1240 by 1240 pixels; Phoenix ICON wide-field infant fundus image; 100° field of view (Phoenix ICON):
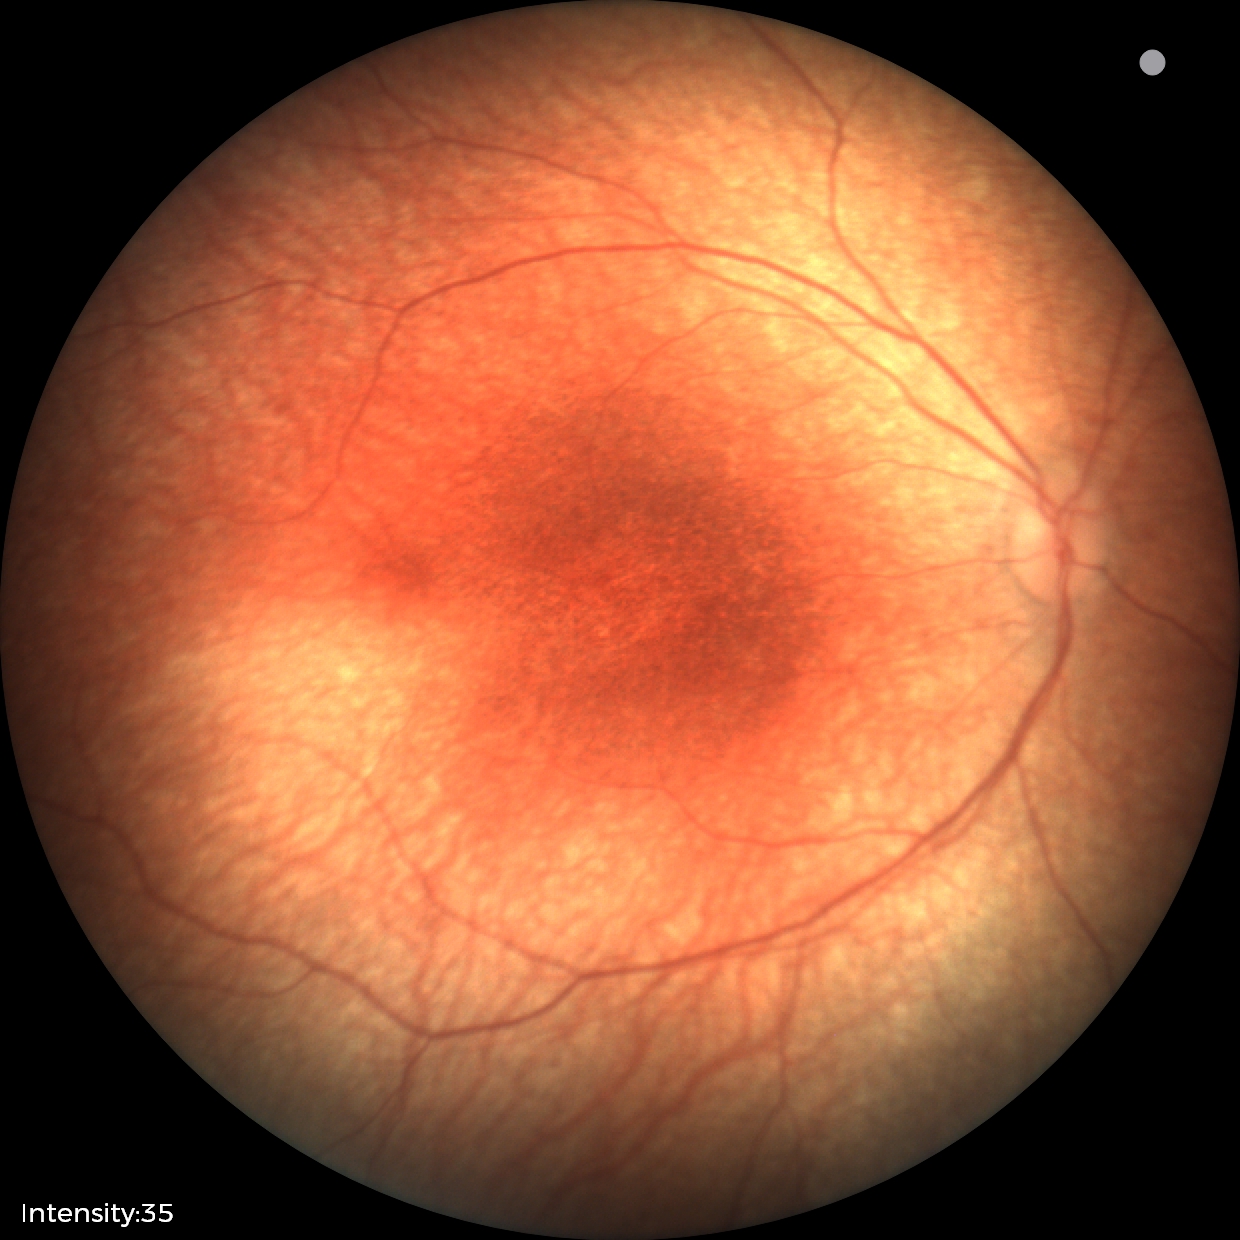
Finding = no pathology identified.